CFP: 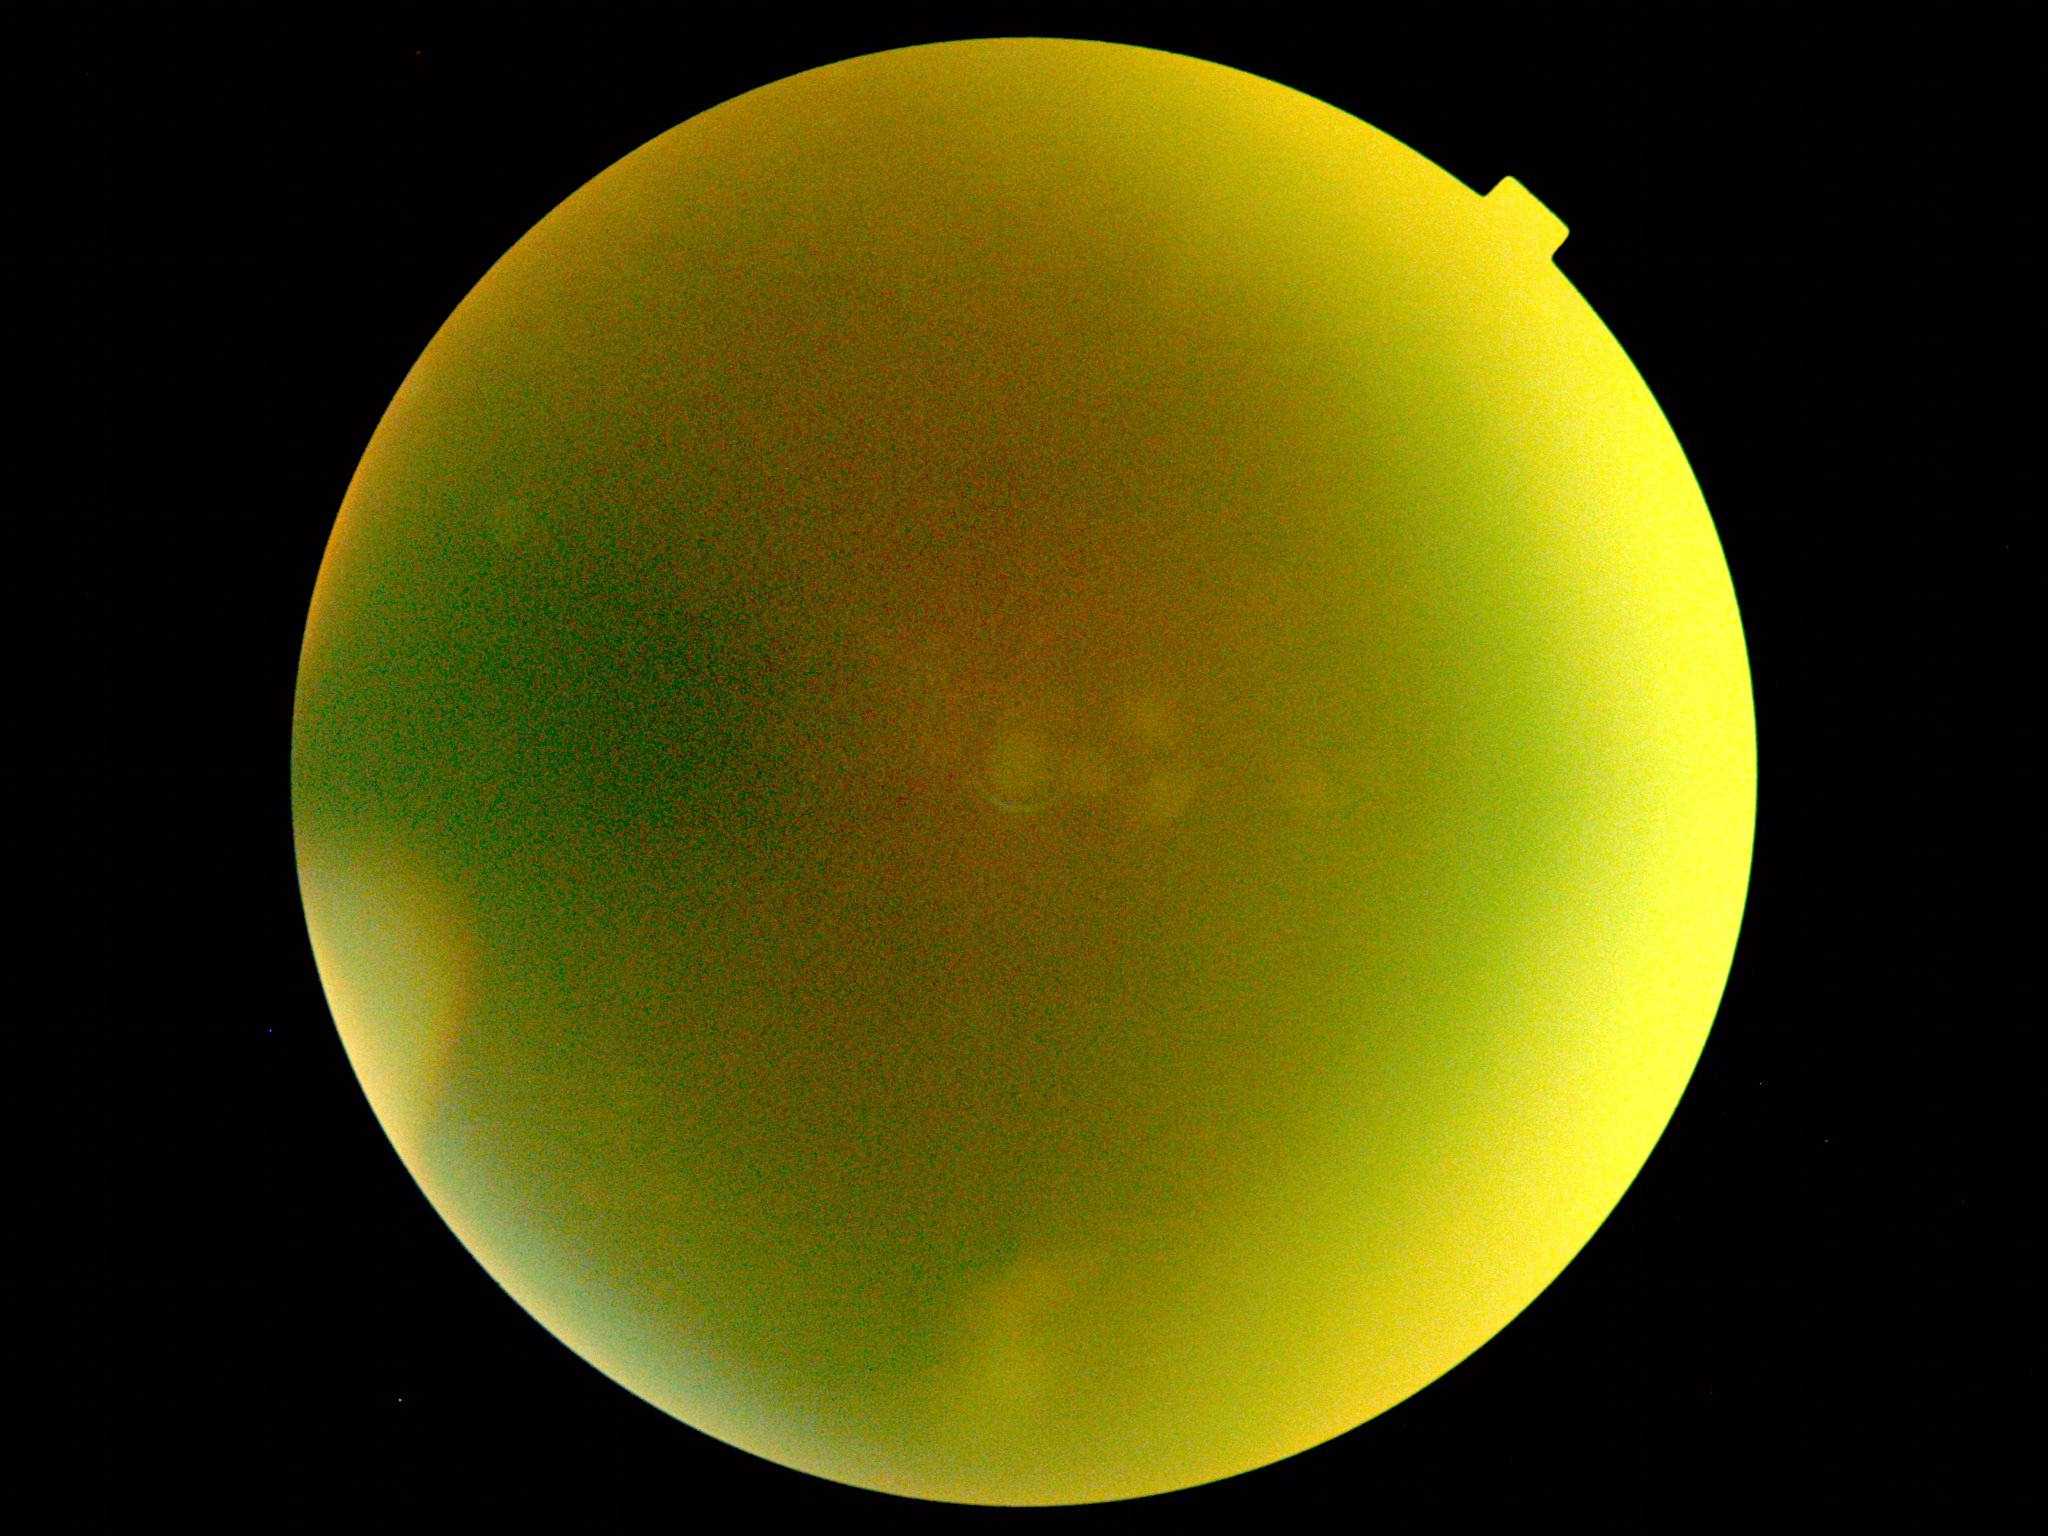

DR stage: ungradable due to poor image quality.